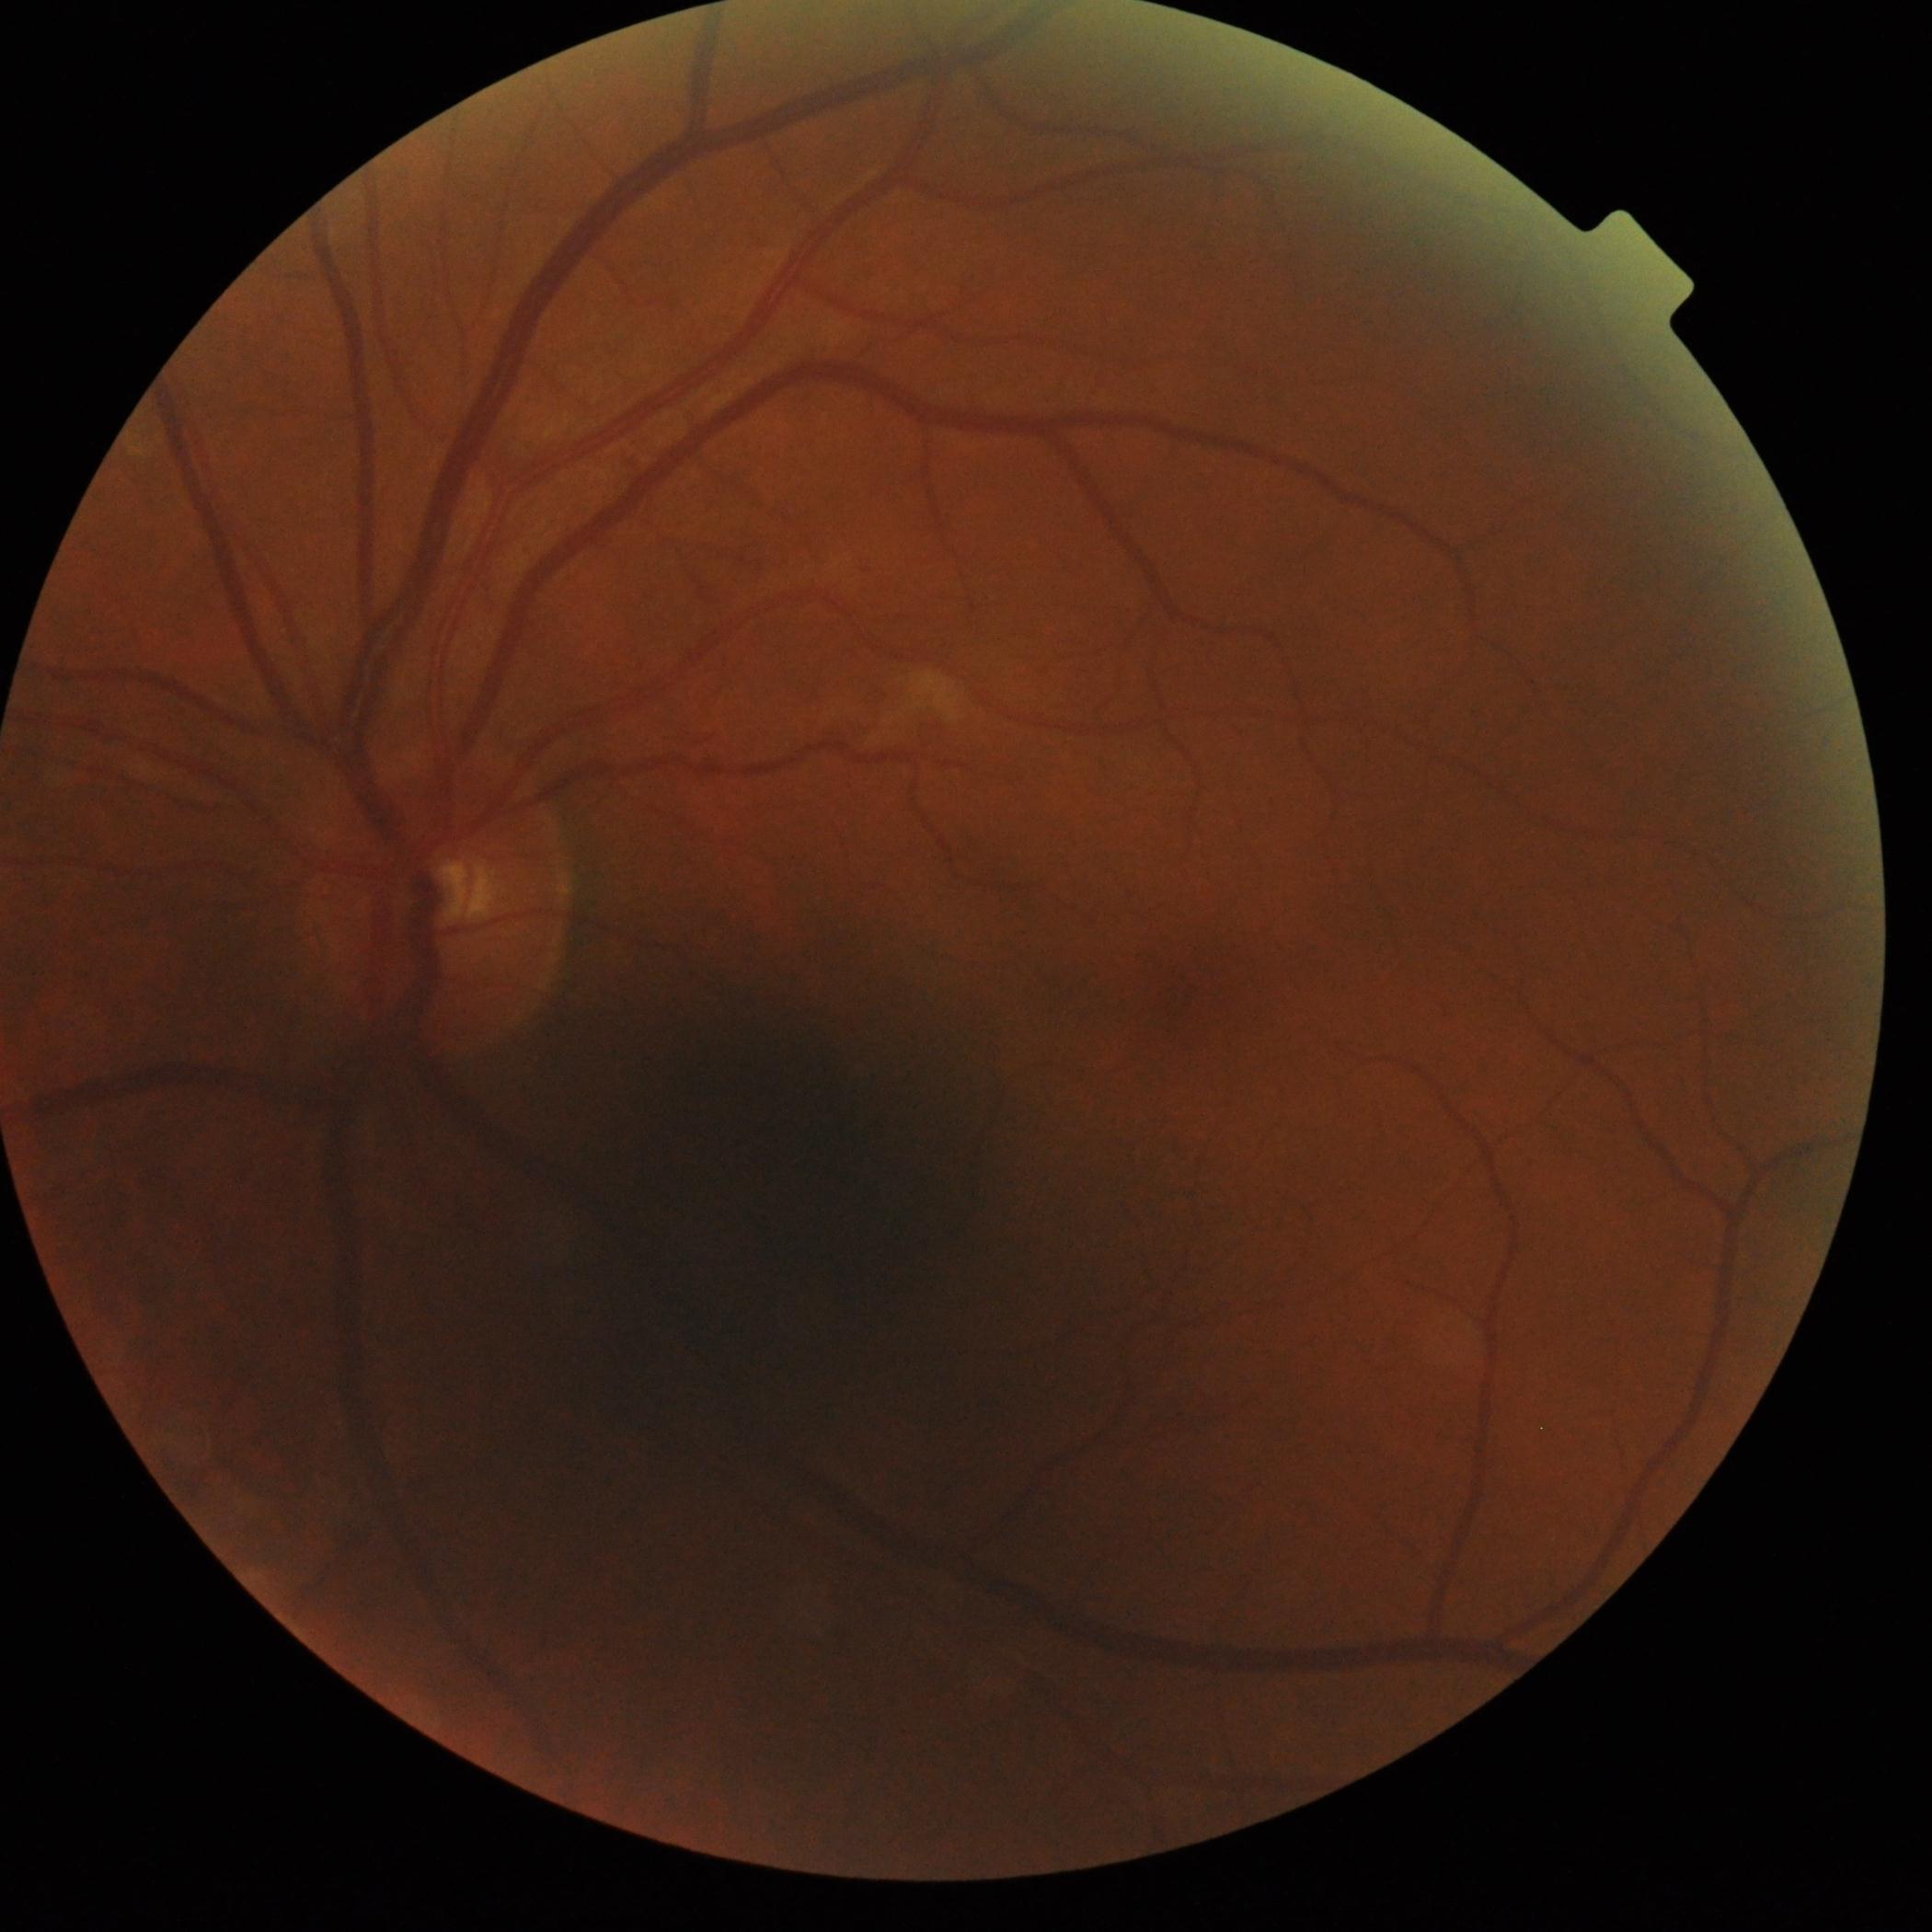
Annotations:
• retinopathy grade — 2 (moderate NPDR)